Ultra-widefield (UWF) fundus image:
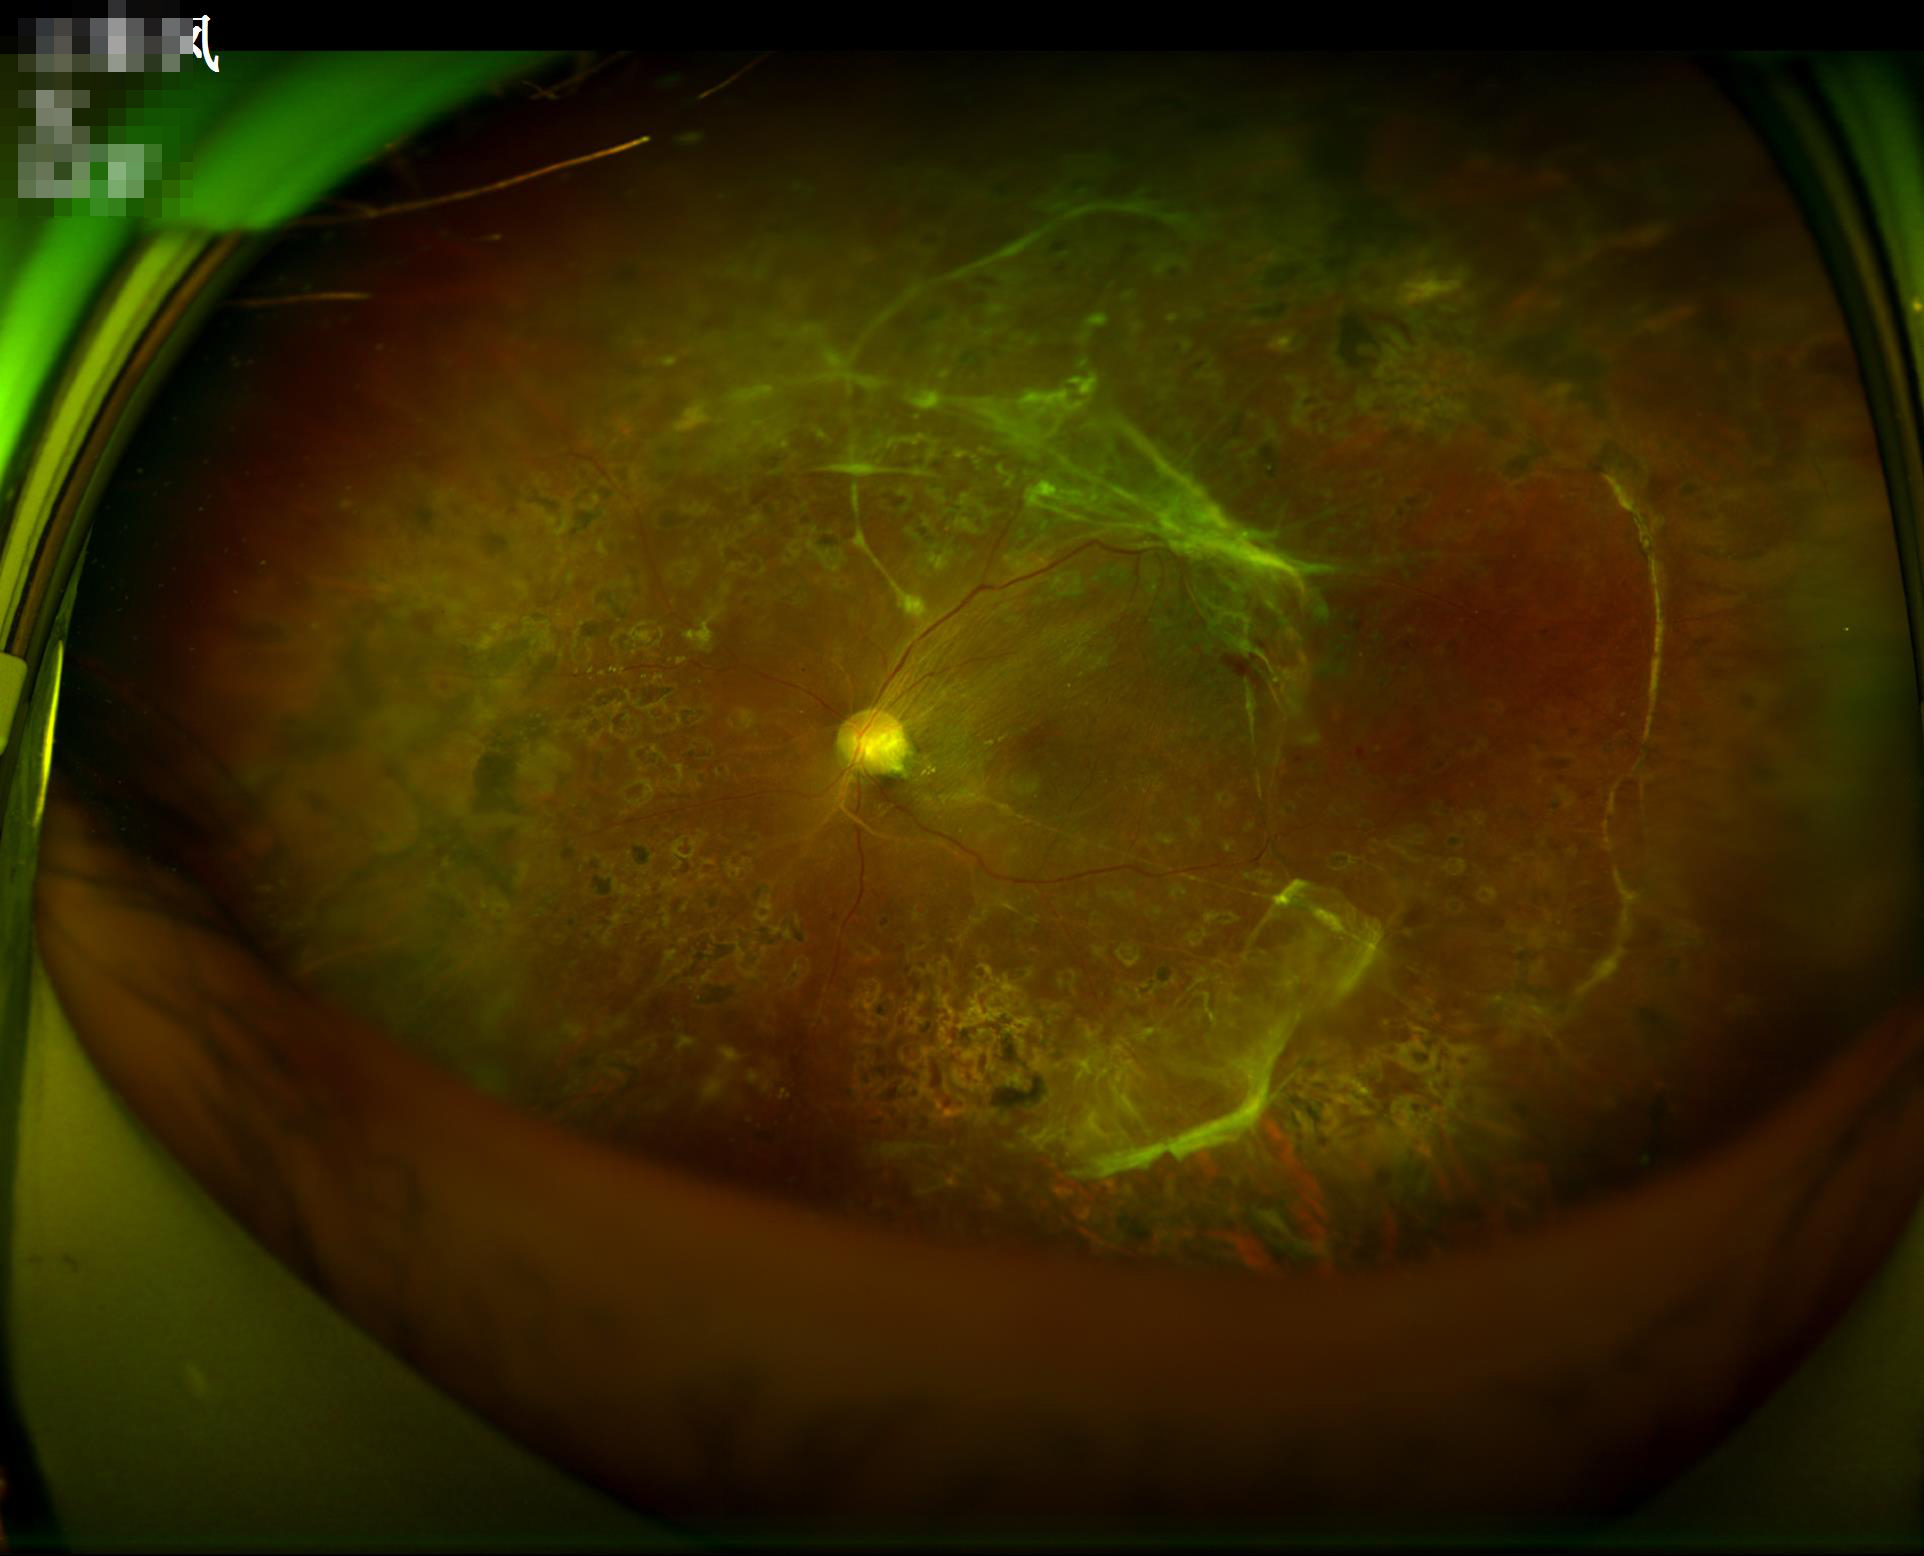 Out of focus; structures are indistinct.
Good dynamic range.
Overall image quality is good.